CFP · 1932 by 1932 pixels · 45-degree field of view.
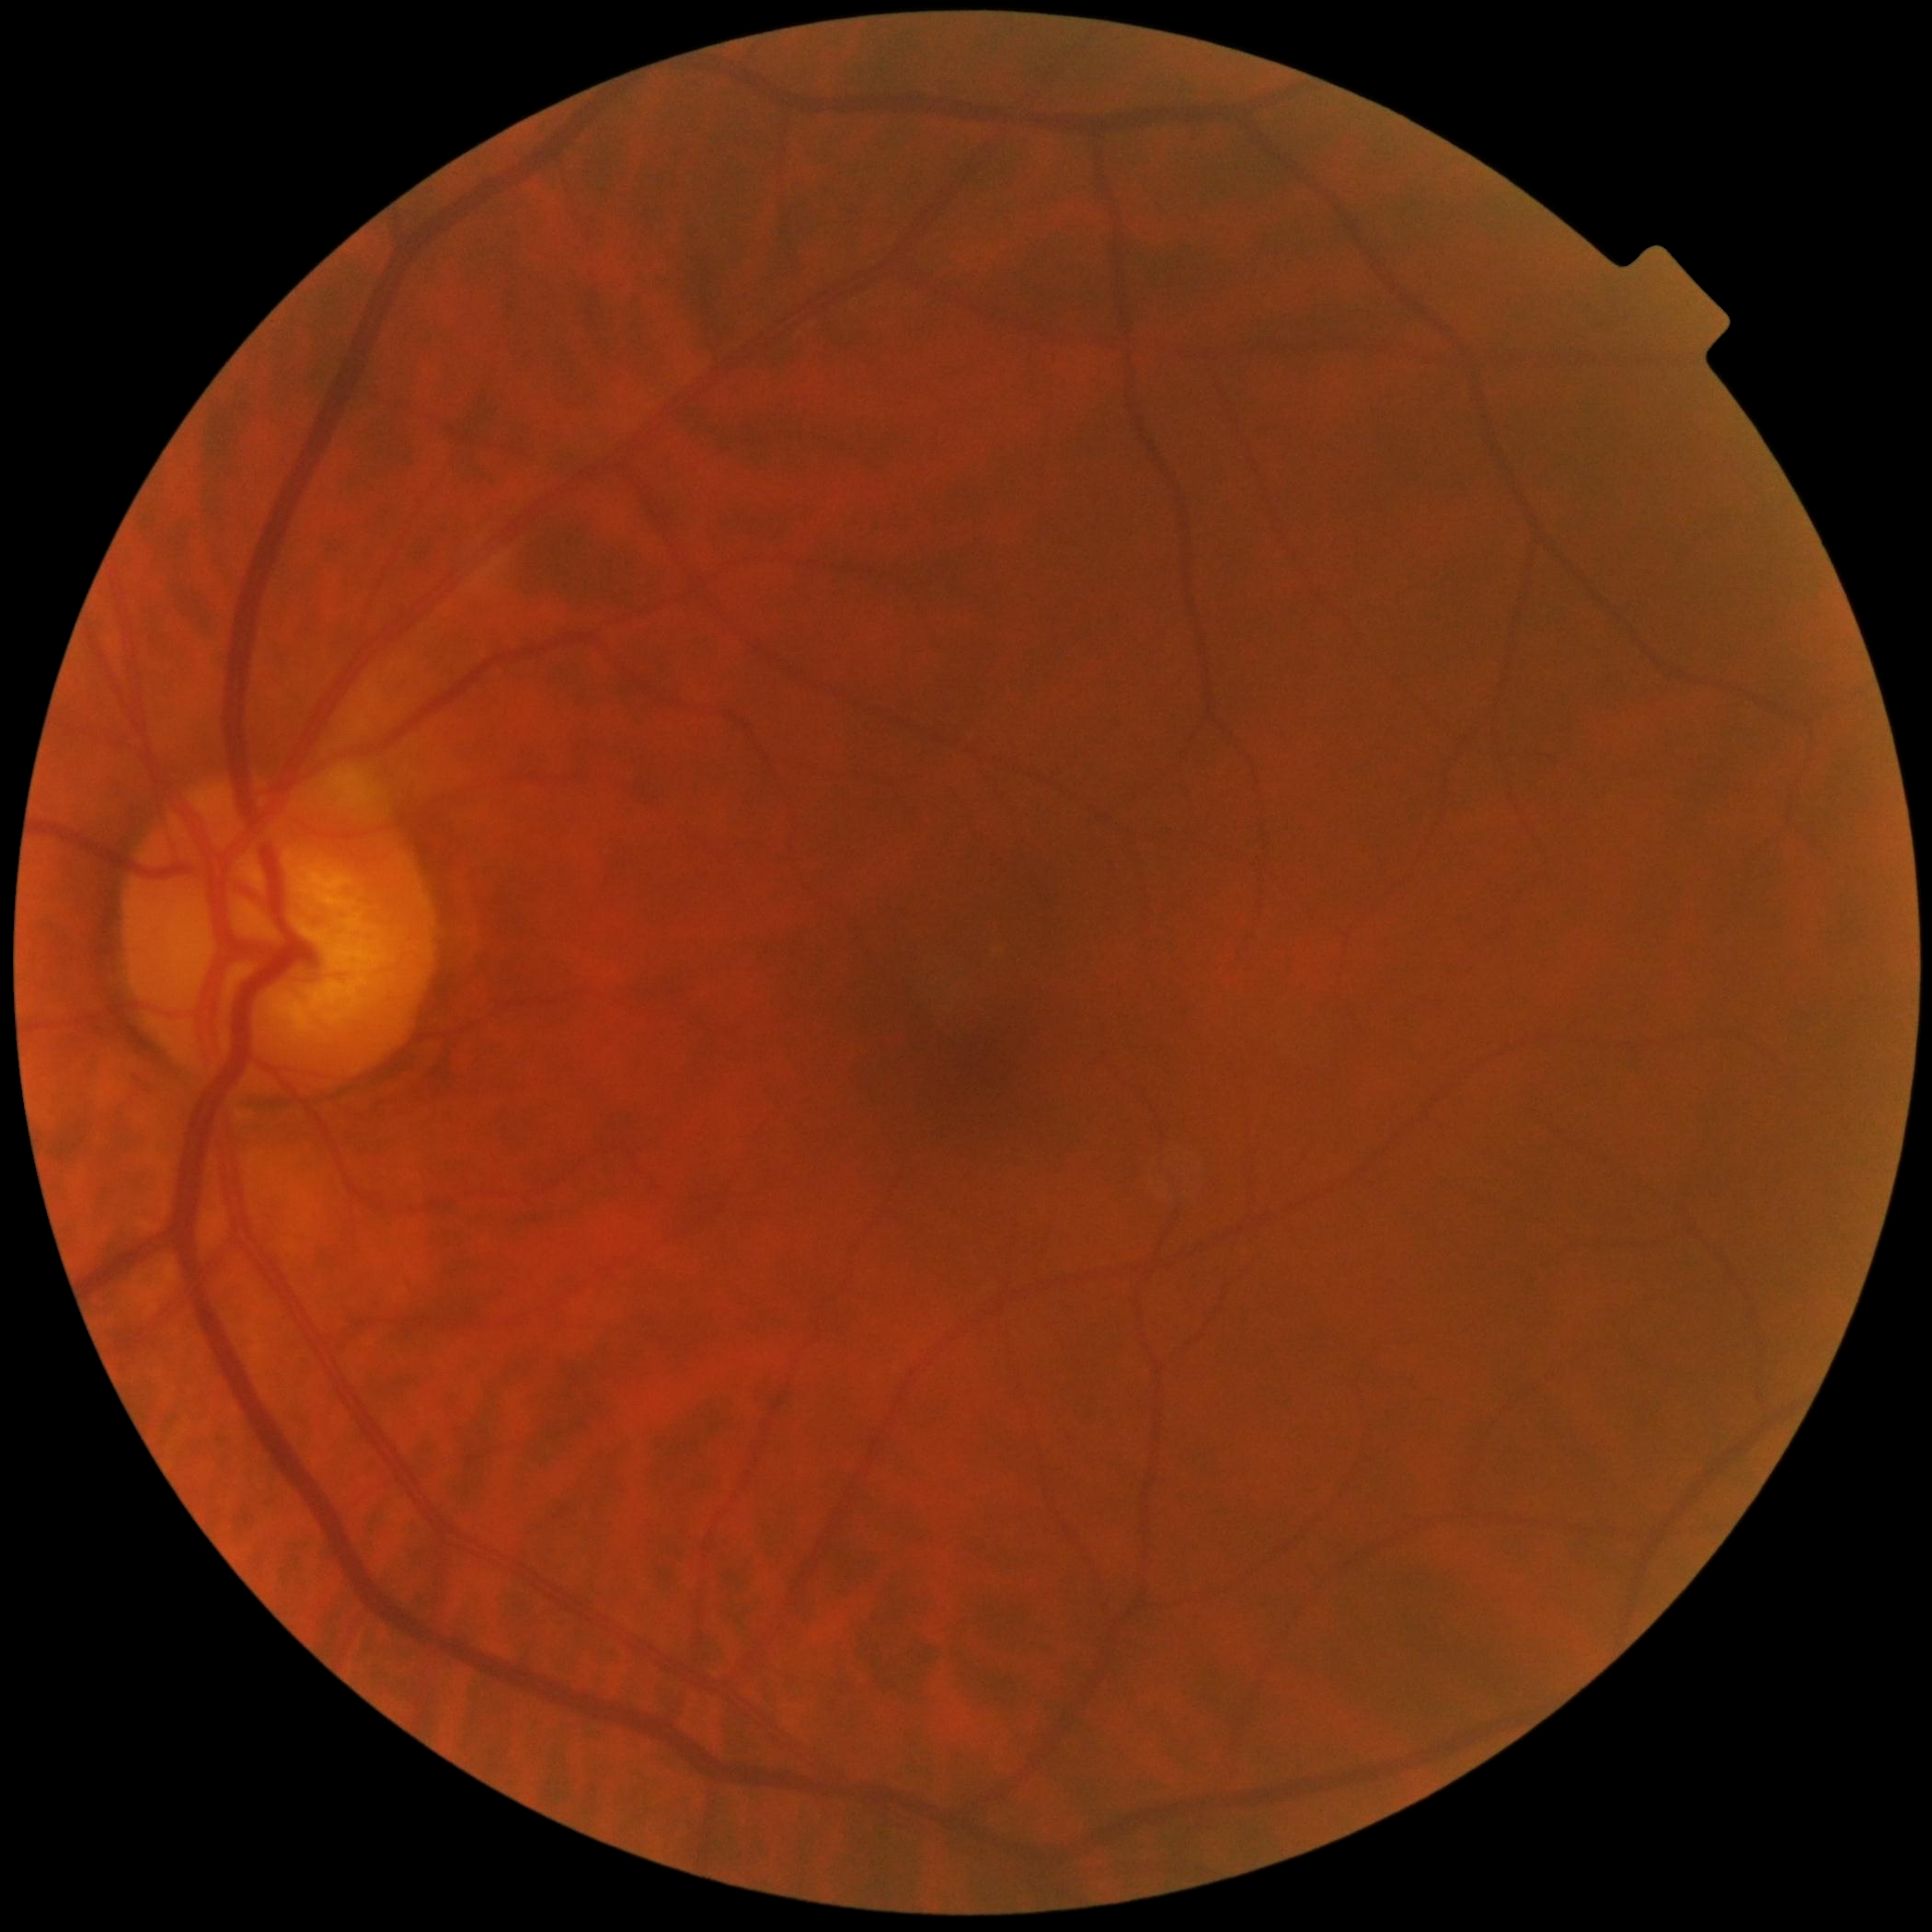 Findings:
• diabetic retinopathy grade — 0/4